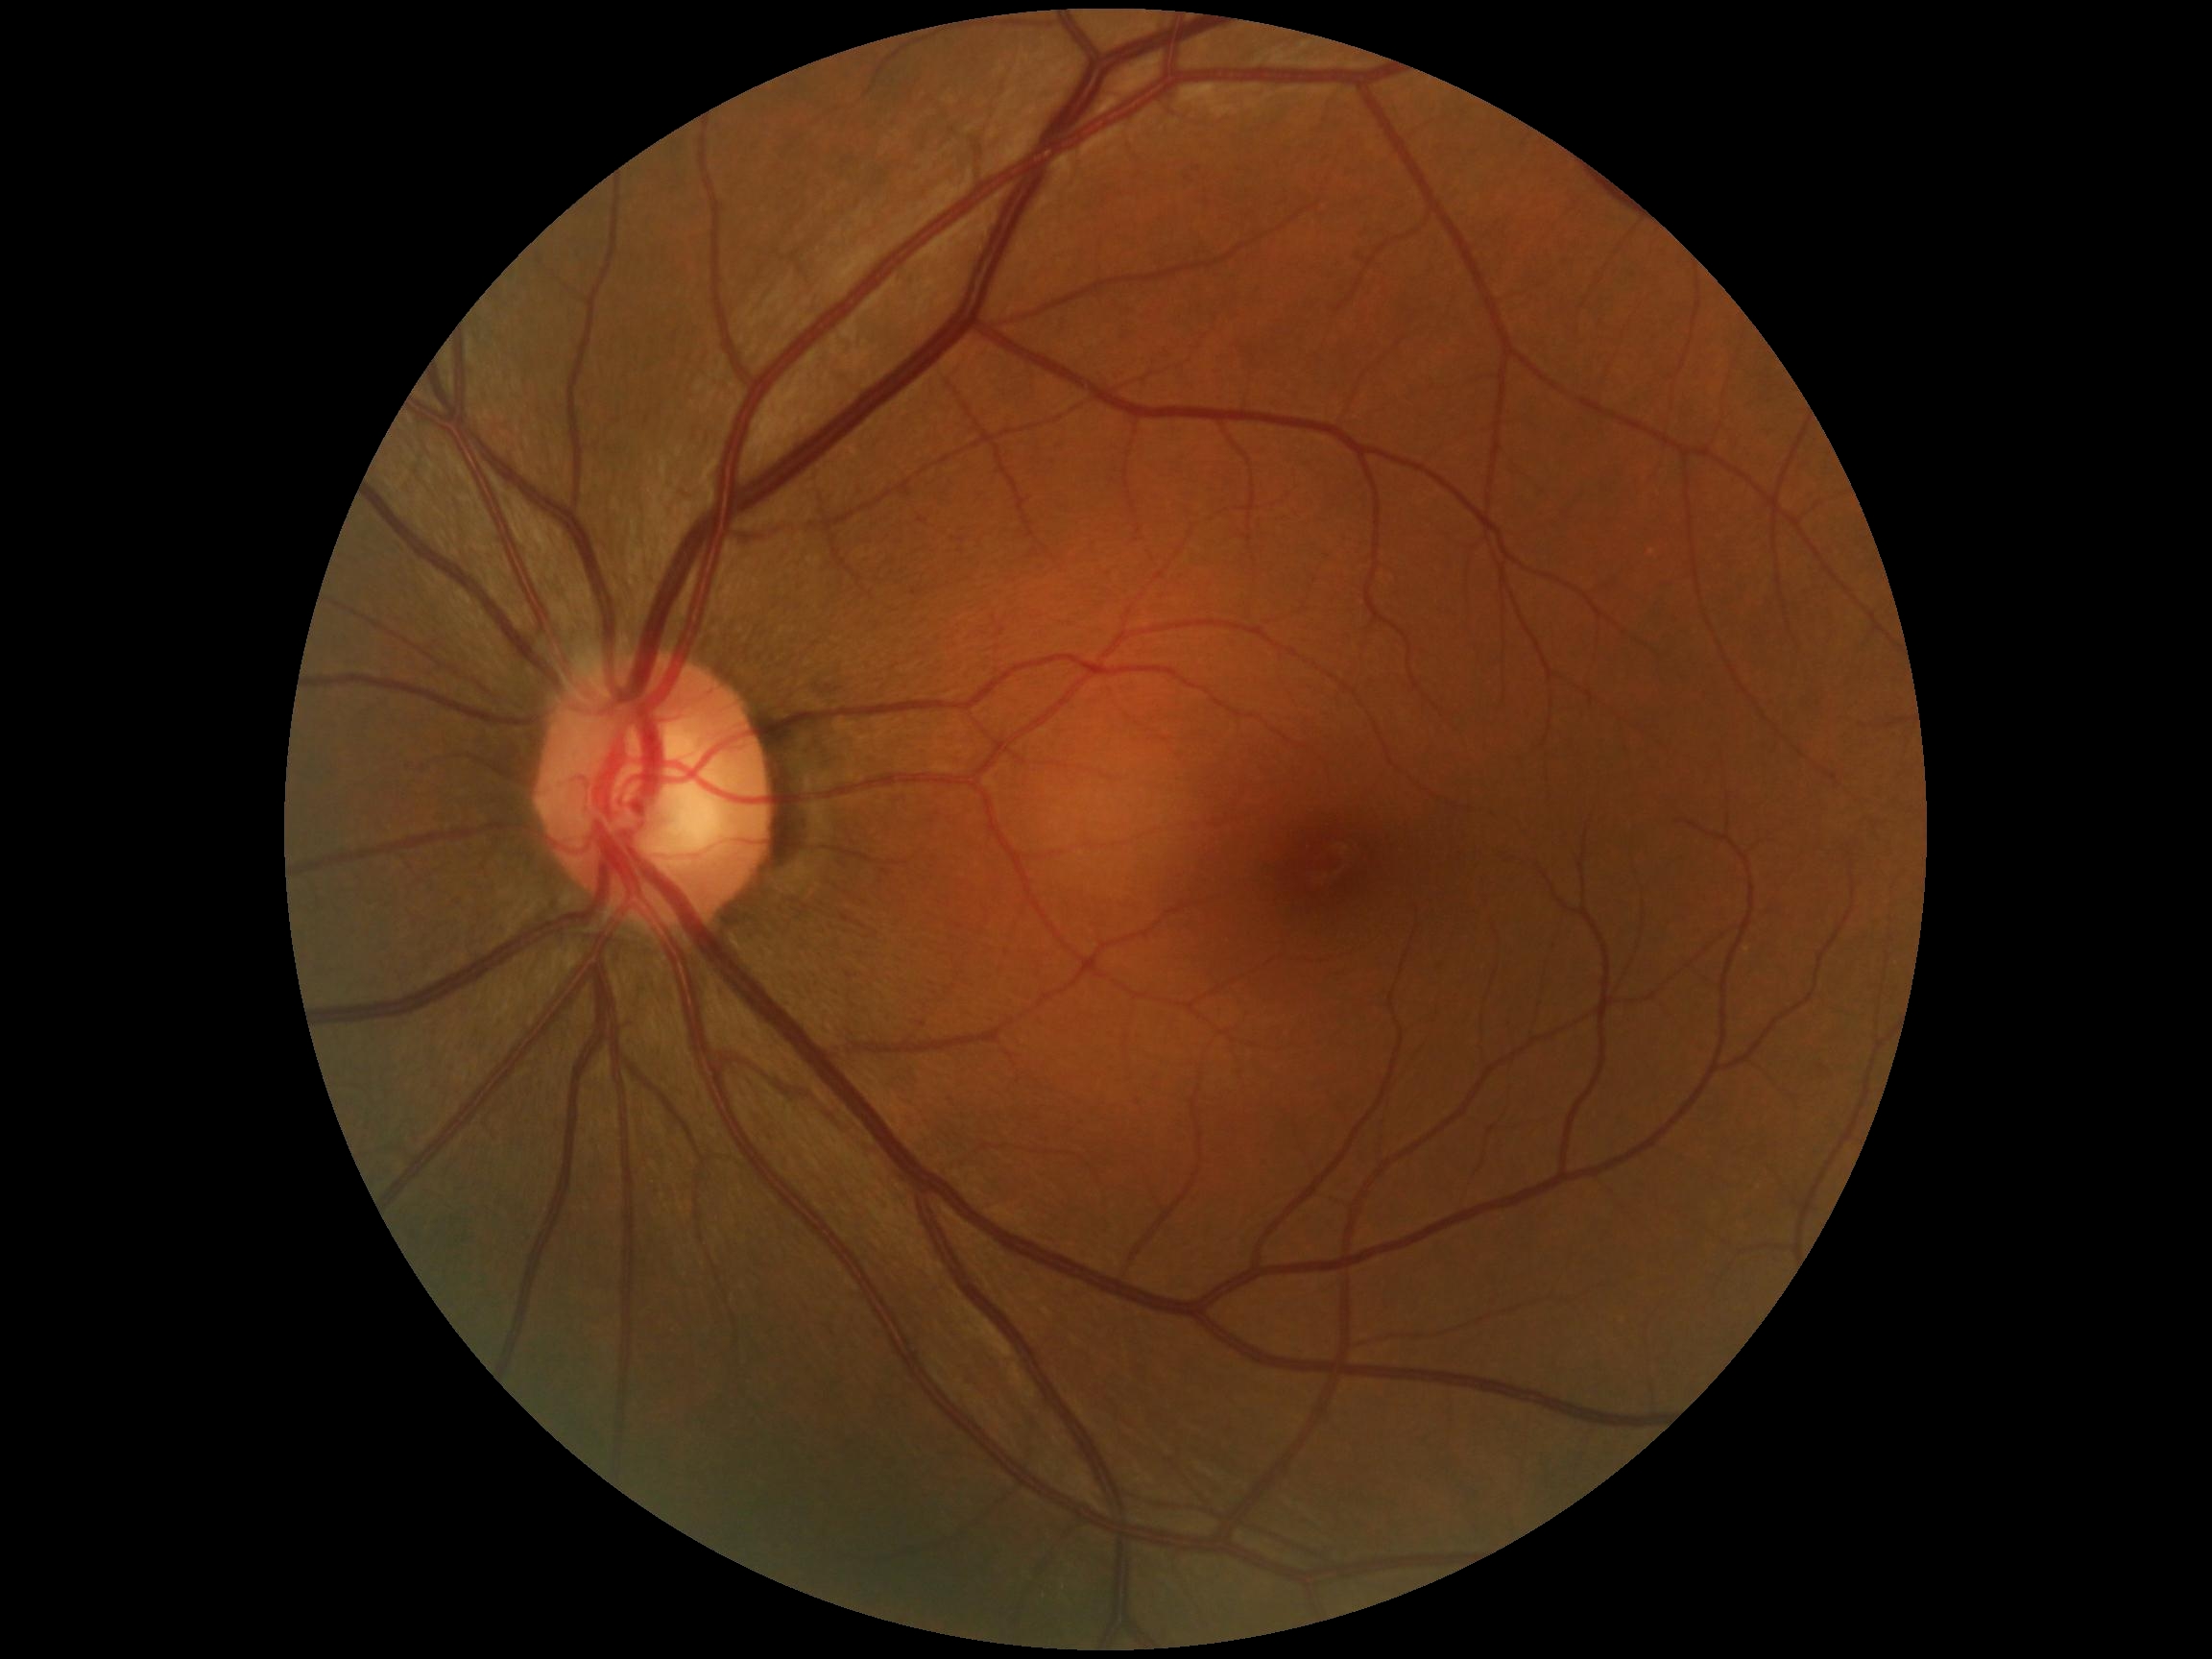 DR stage: no apparent retinopathy (grade 0).